130° field of view (Clarity RetCam 3) · RetCam wide-field infant fundus image · 640 by 480 pixels: 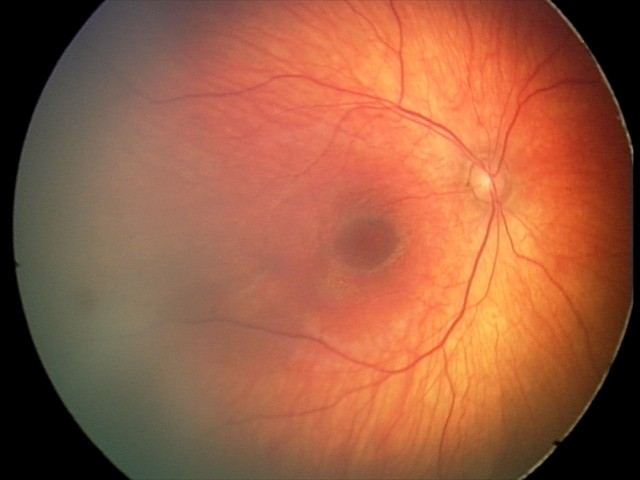

Examination diagnosed as retinal hemorrhages.